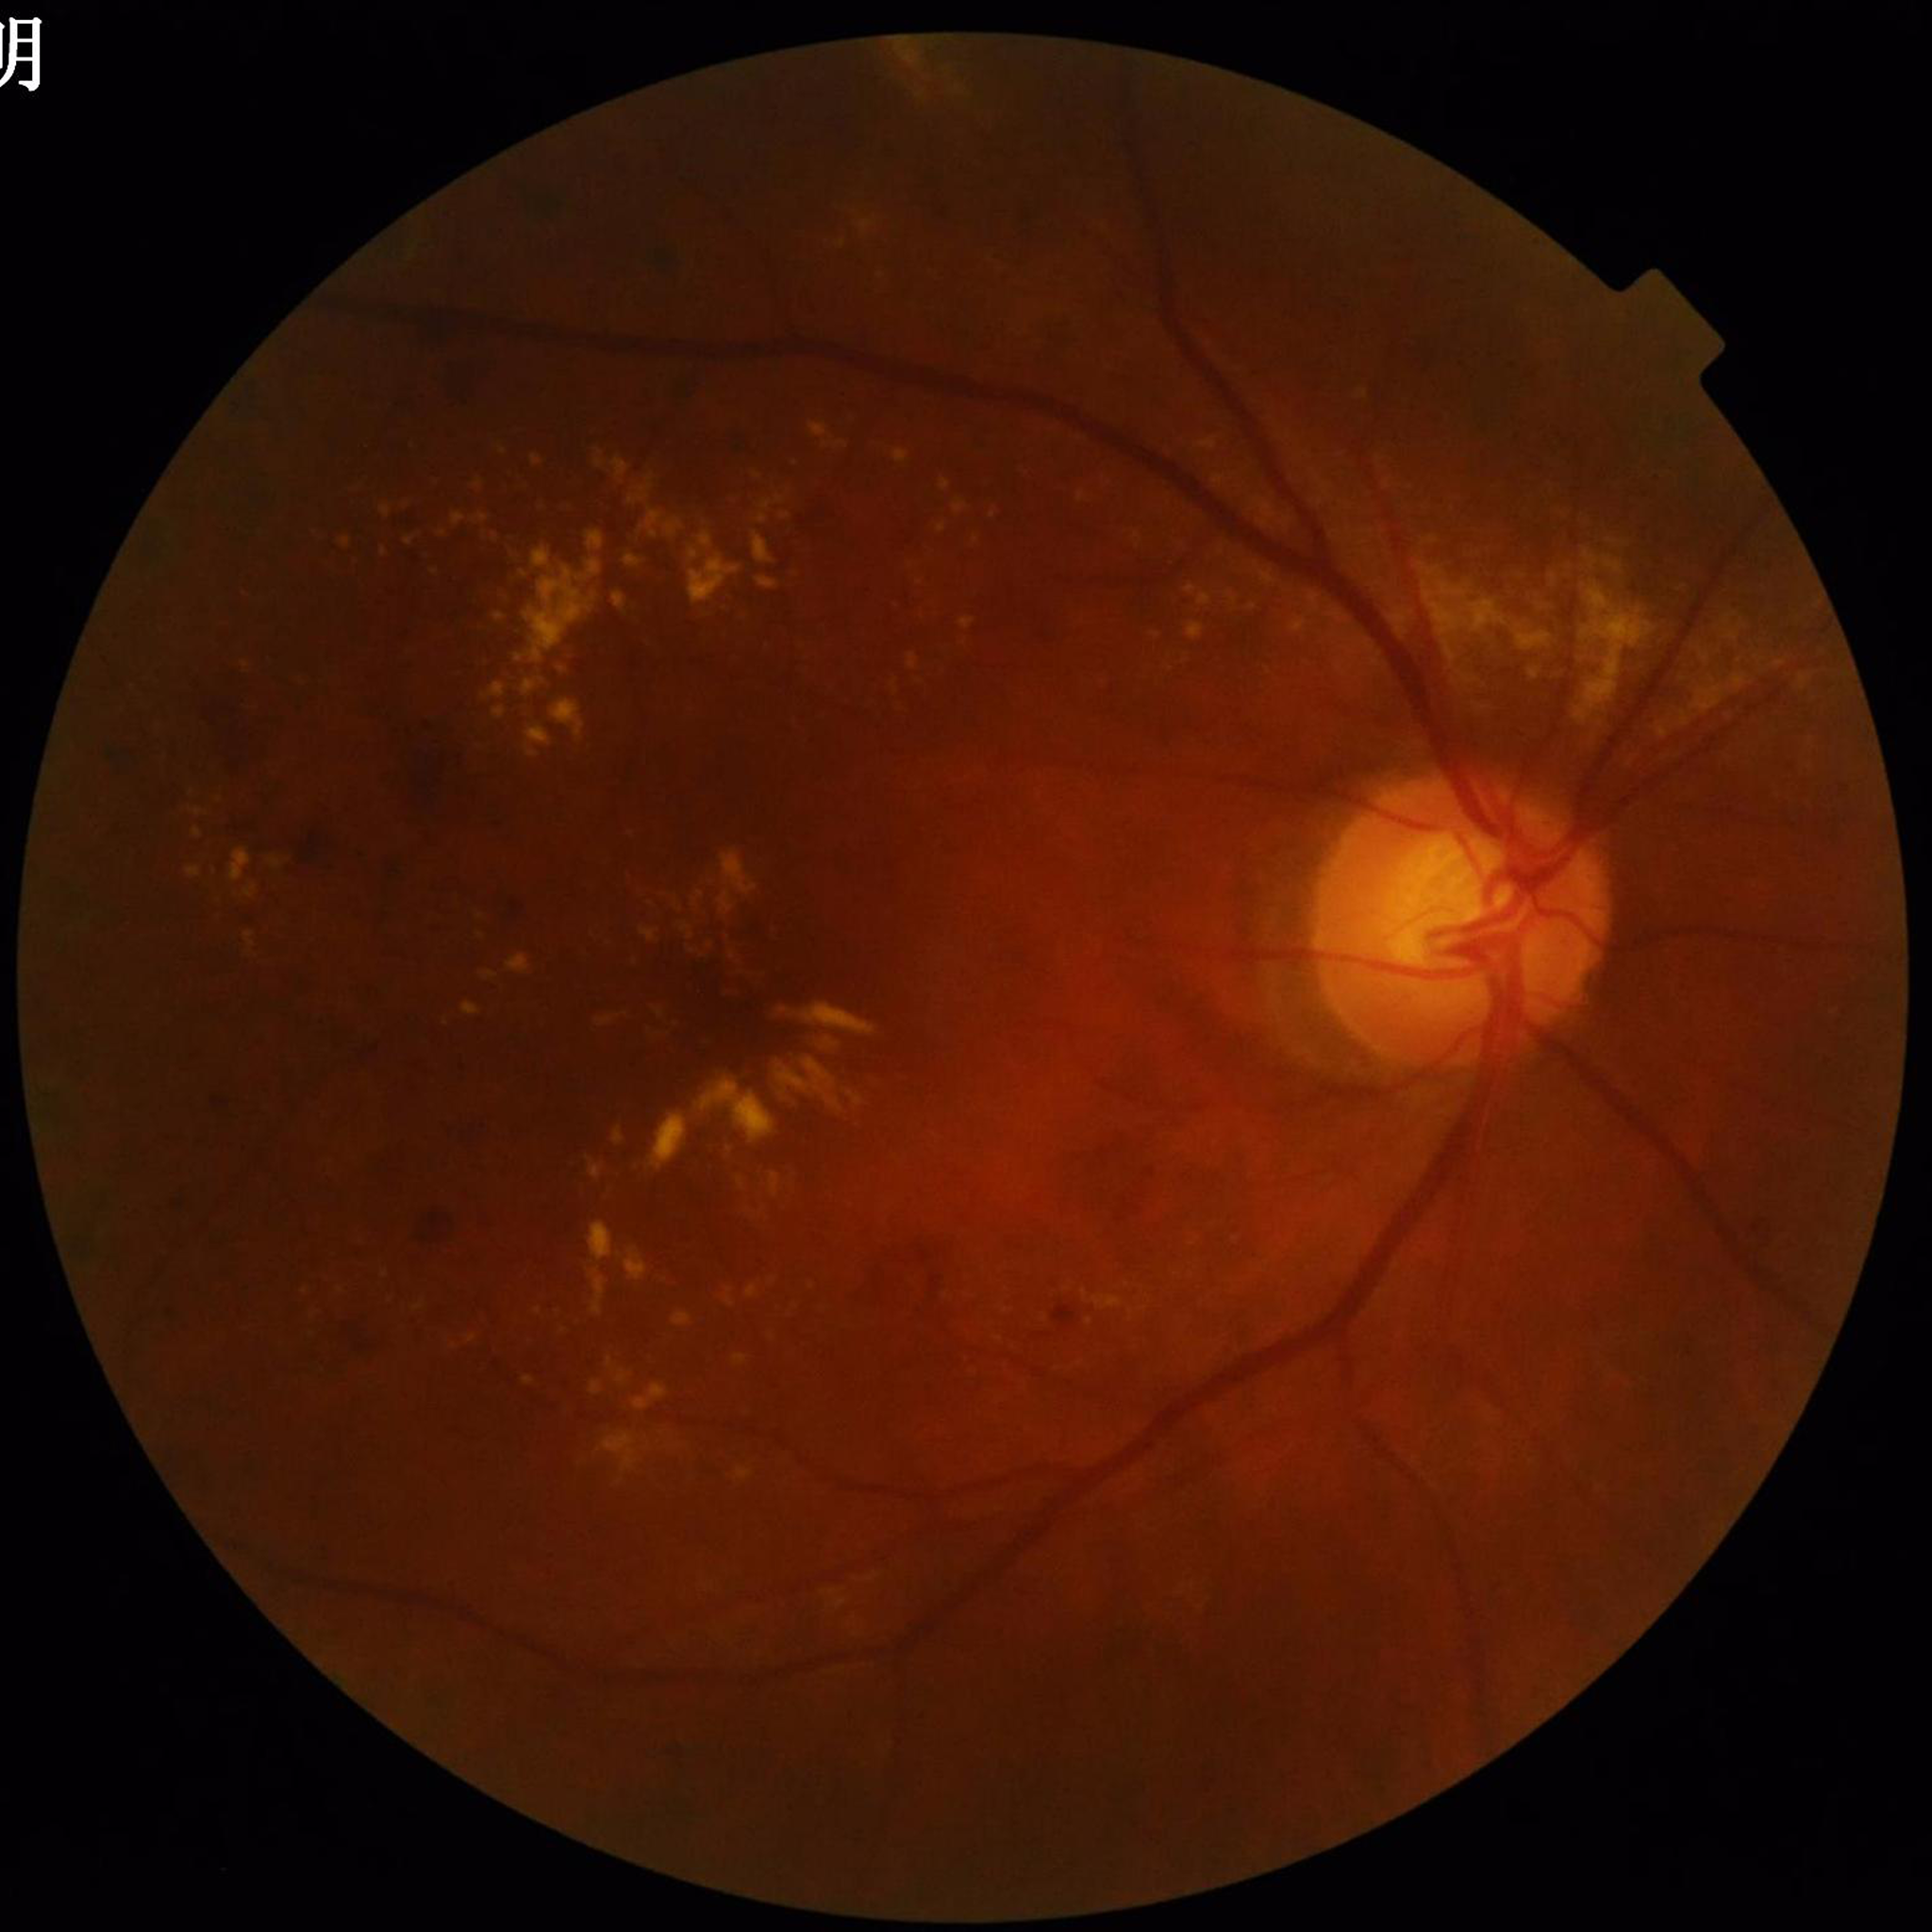 Diagnosis: DR